FOV: 45 degrees:
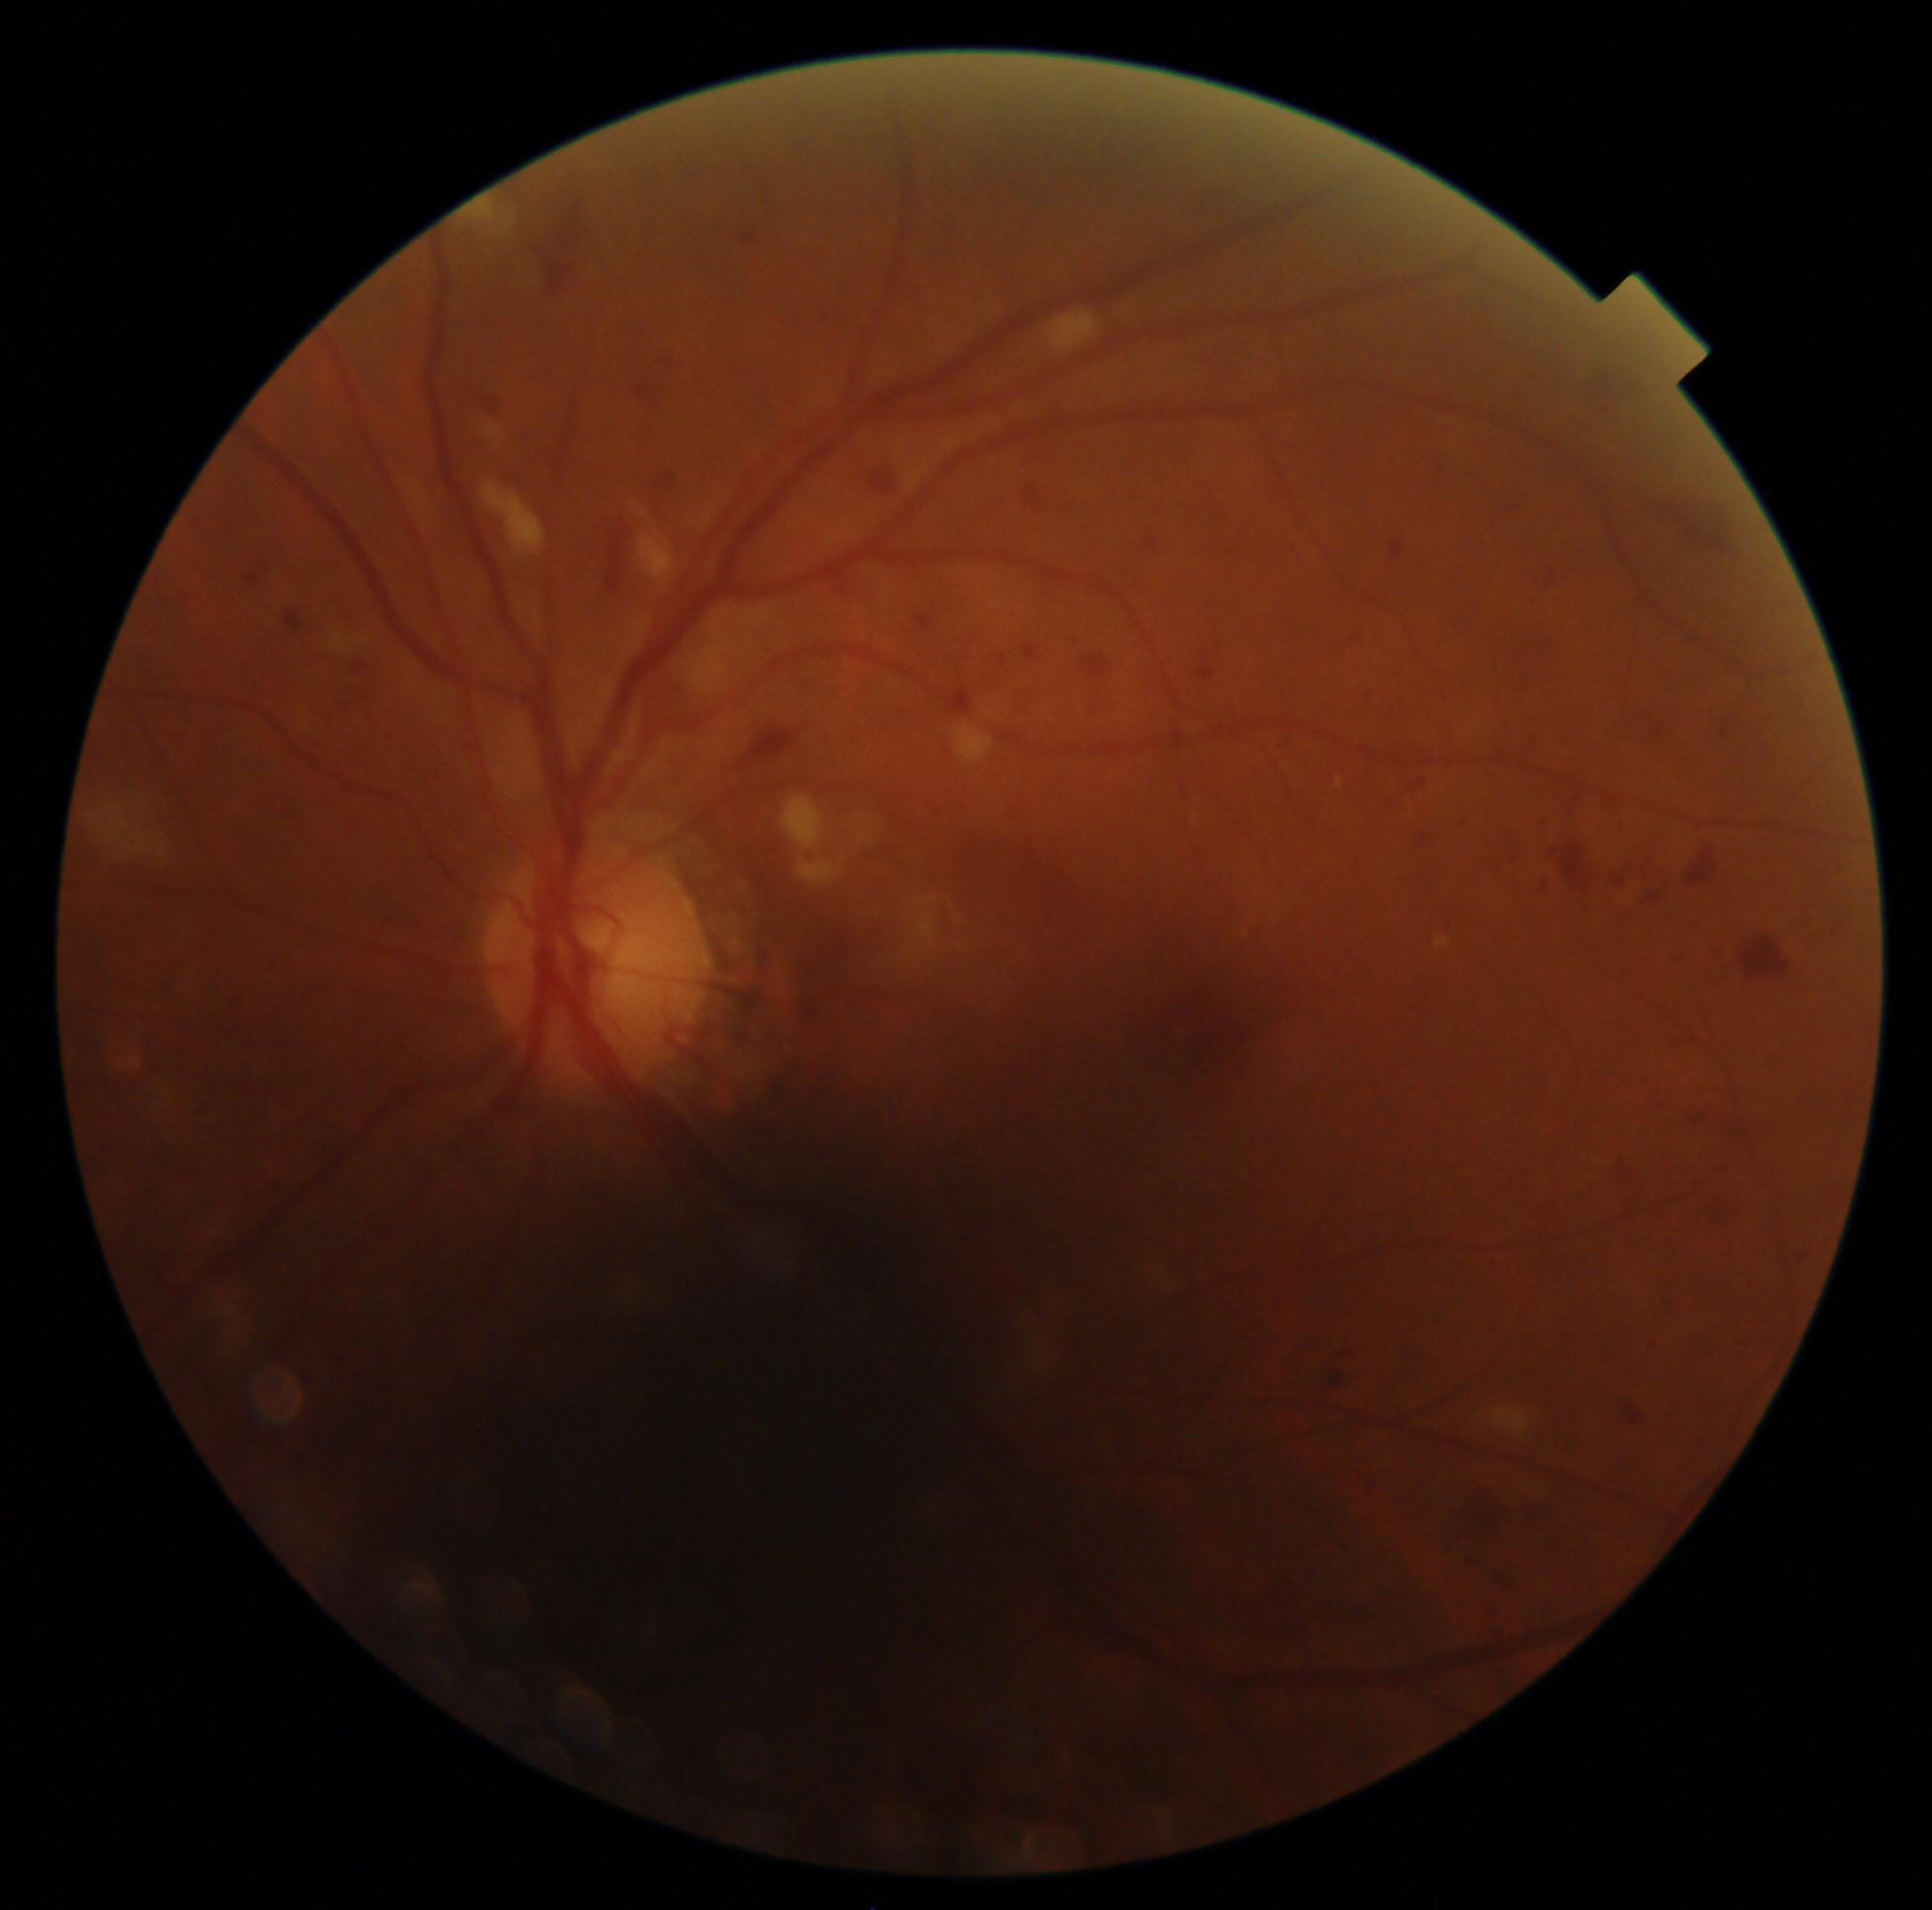

DR stage: moderate non-proliferative diabetic retinopathy (grade 2). The retinopathy is classified as non-proliferative diabetic retinopathy.